Retinal fundus photograph:
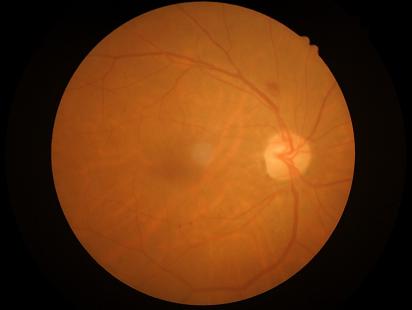
Overall quality is good and the image is gradable.
Image is sharp throughout the field.
Illumination and color balance are good.
Contrast is good.